Posterior pole view · dilated-pupil acquisition · CFP:
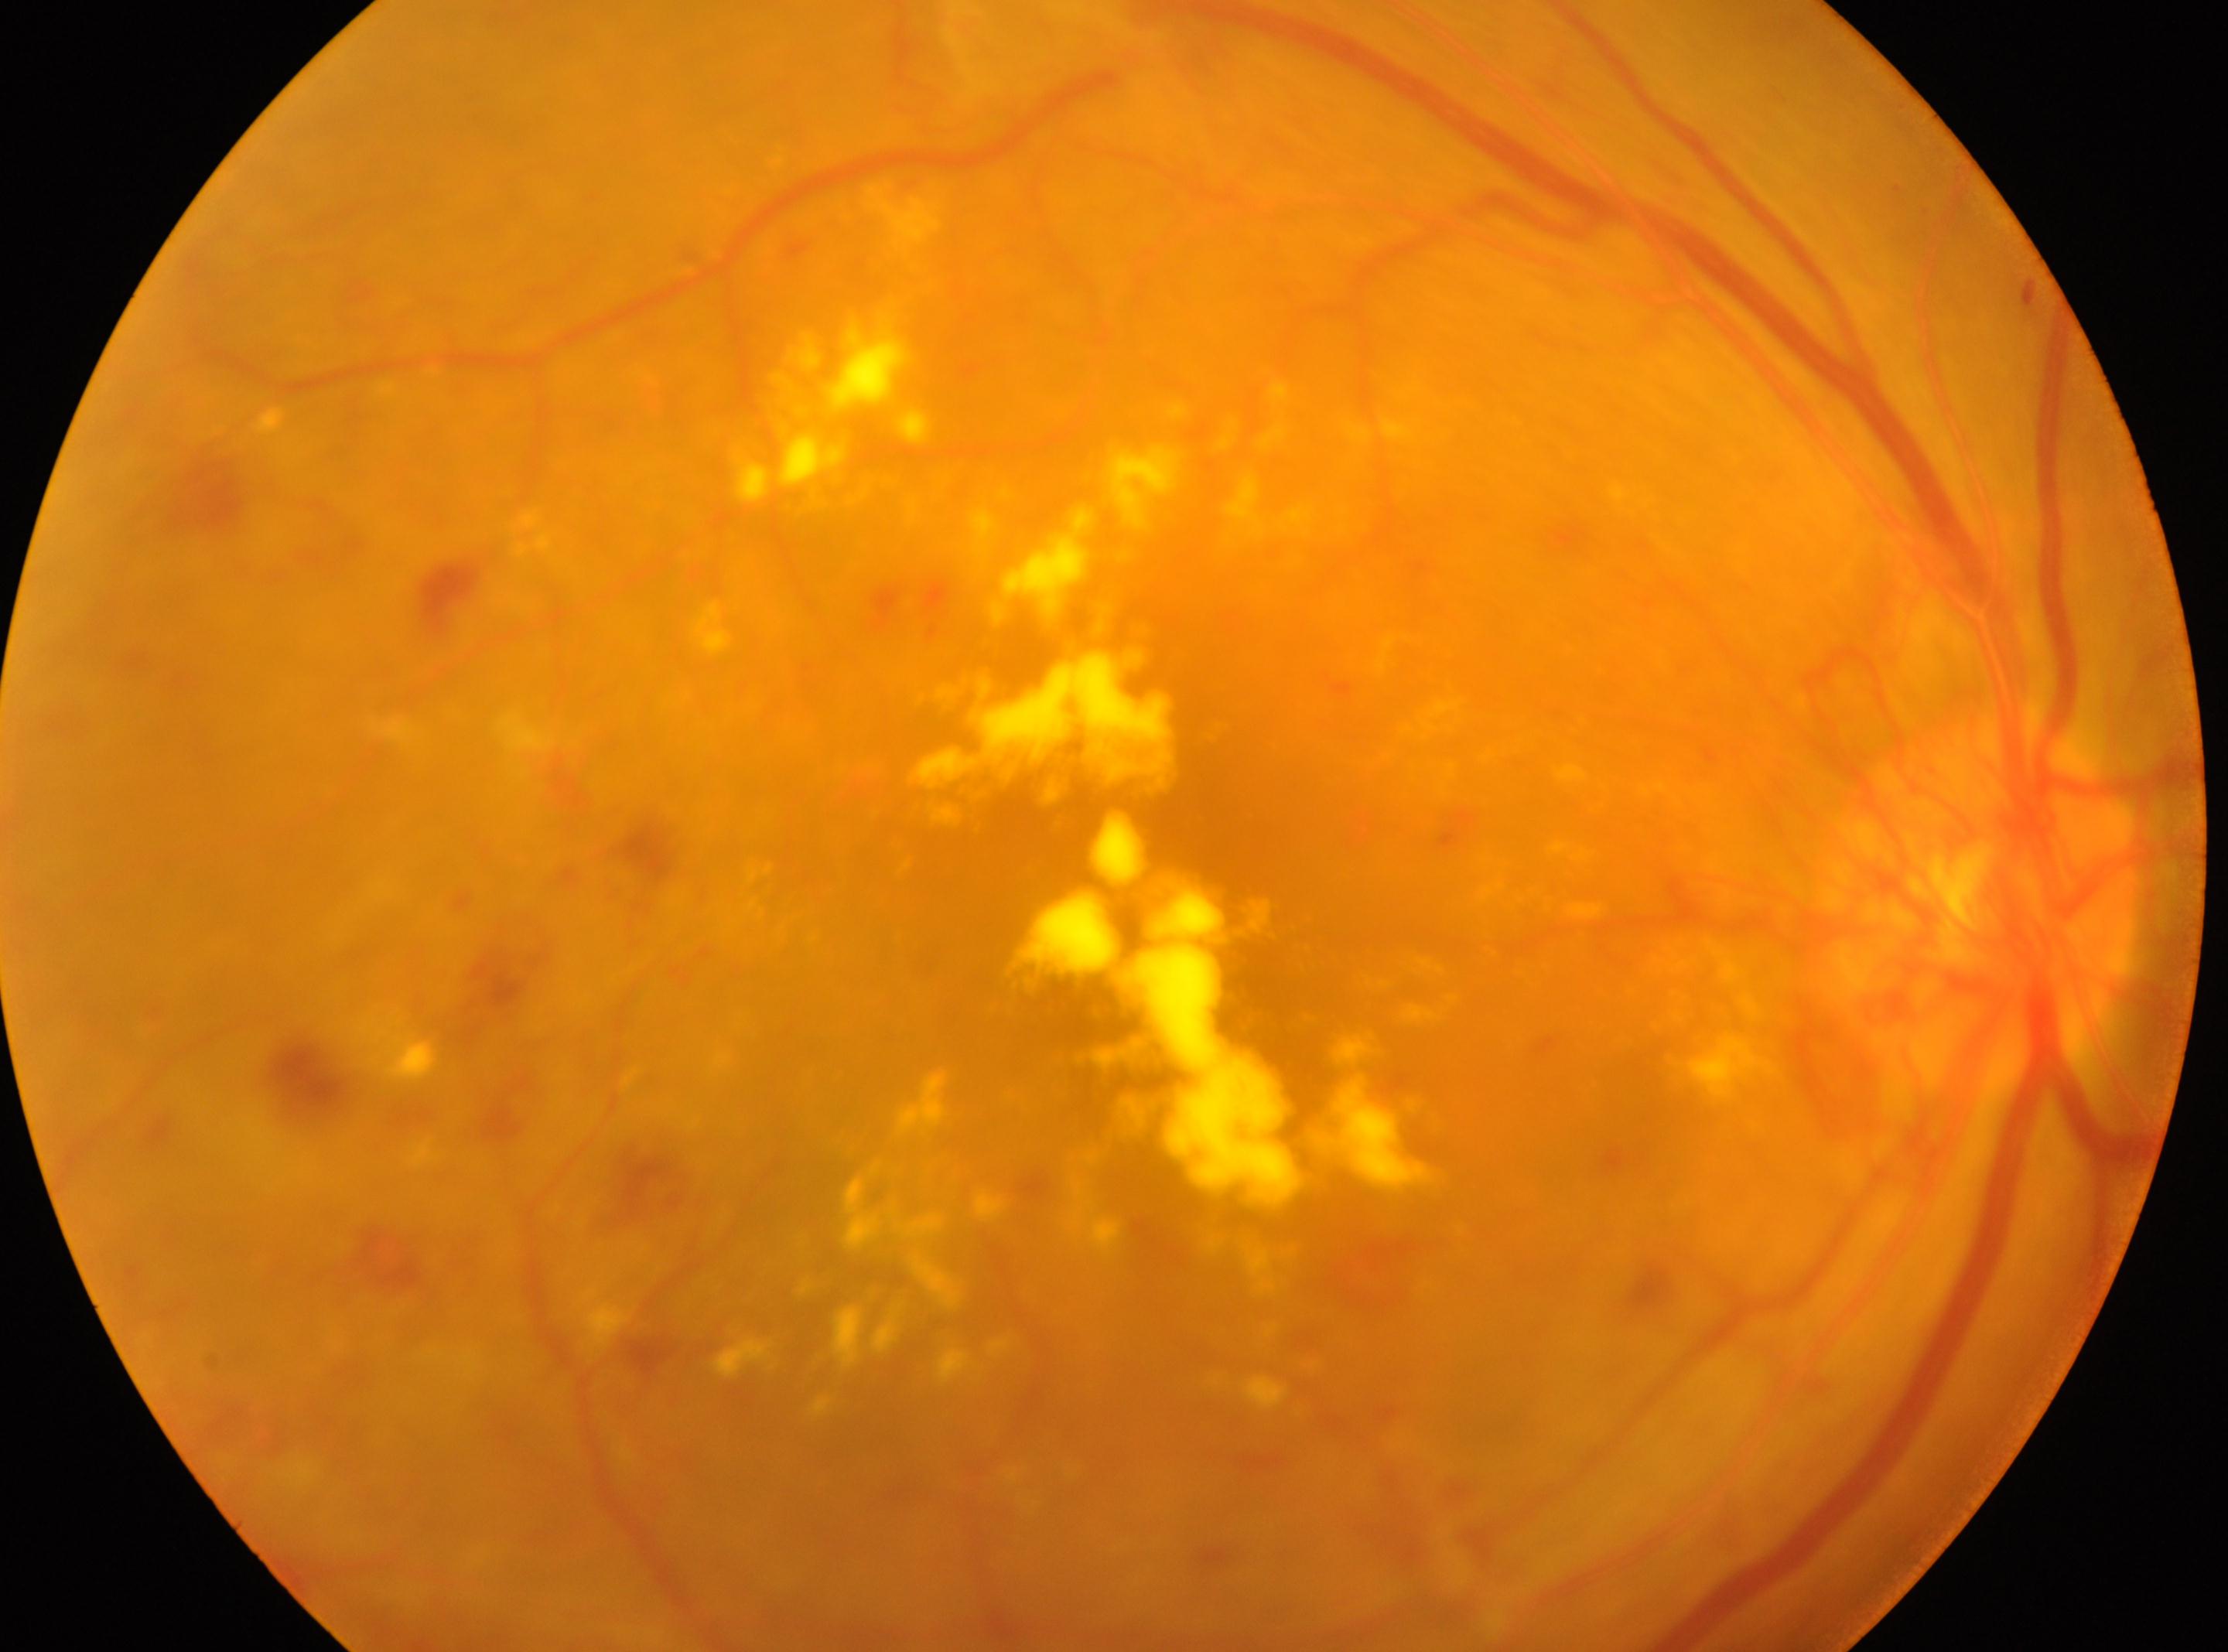

proliferative diabetic retinopathy; diabetic retinopathy grade=4; the optic disc=(x=1981, y=897); fovea center=(x=1230, y=962); OD.